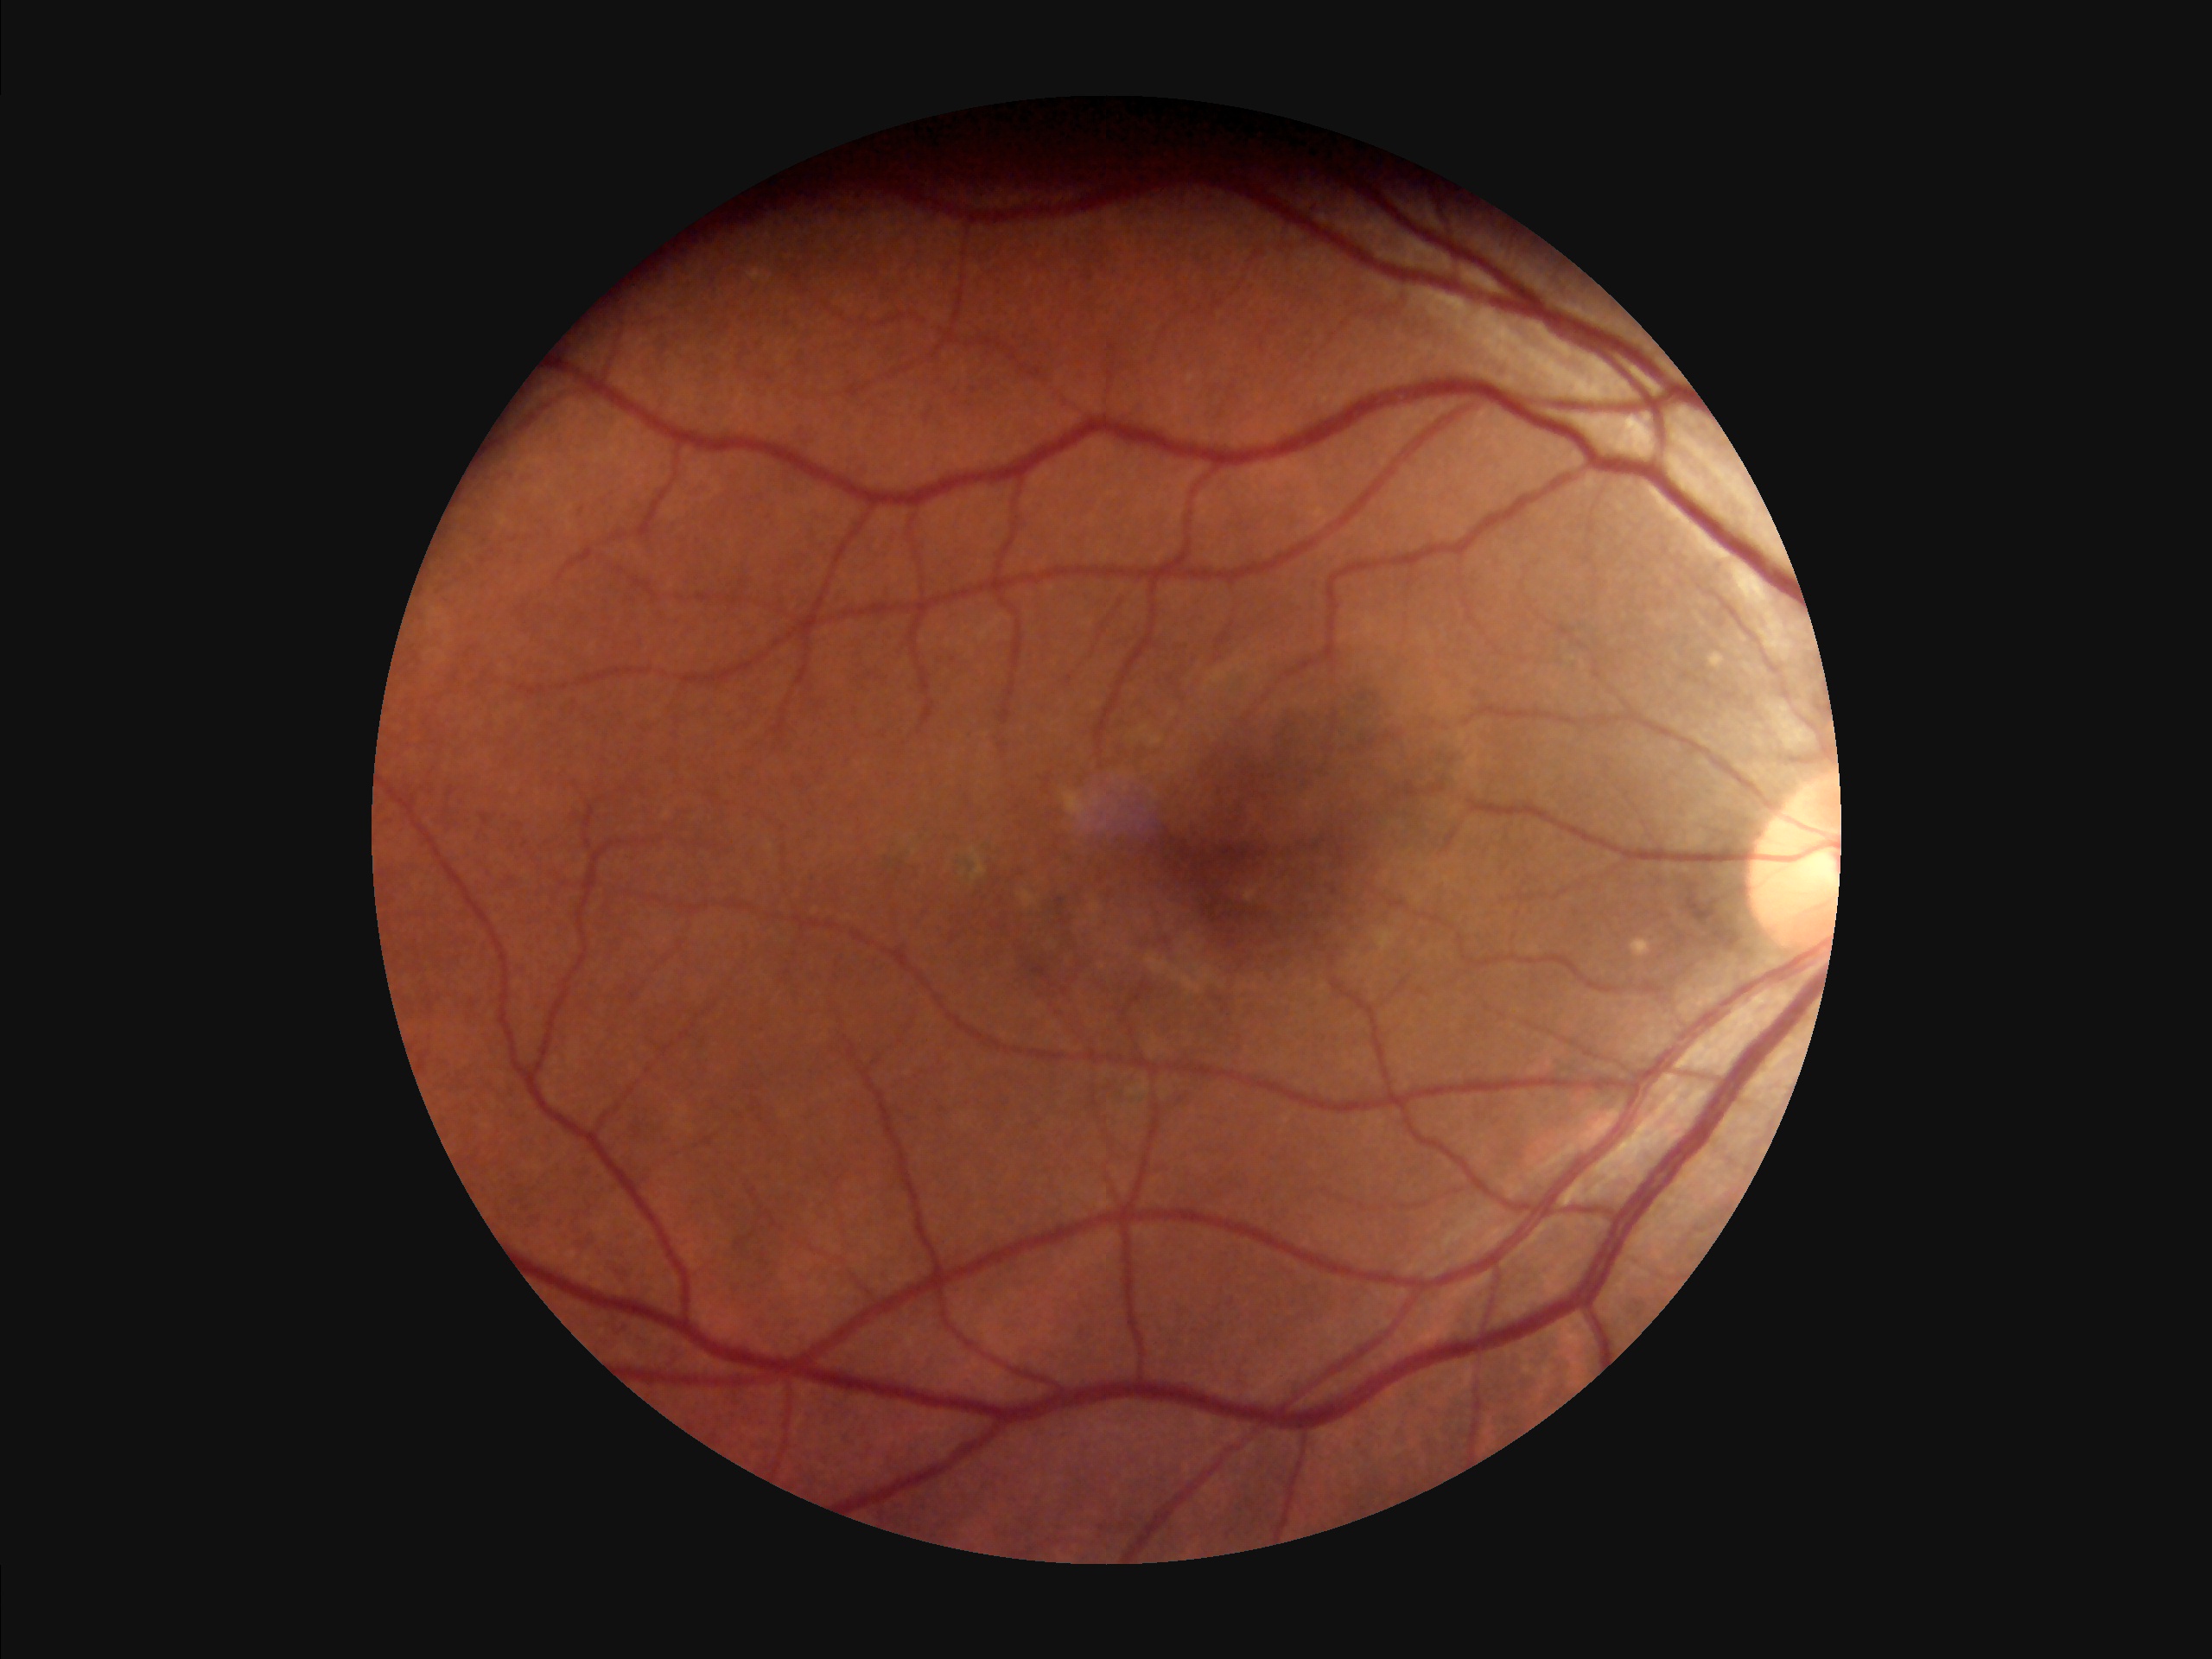
Sharpness: sharp
Overall image quality: satisfactory
Contrast: satisfactory